Nonmydriatic: 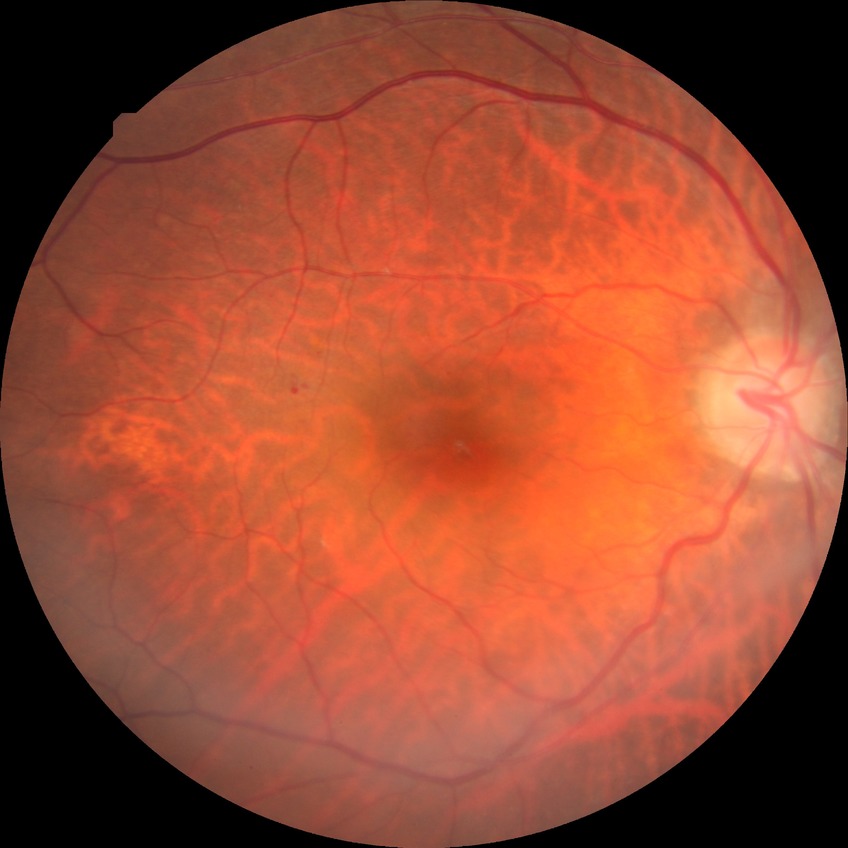
Diabetic retinopathy (DR): SDR (simple diabetic retinopathy).